Color fundus photograph
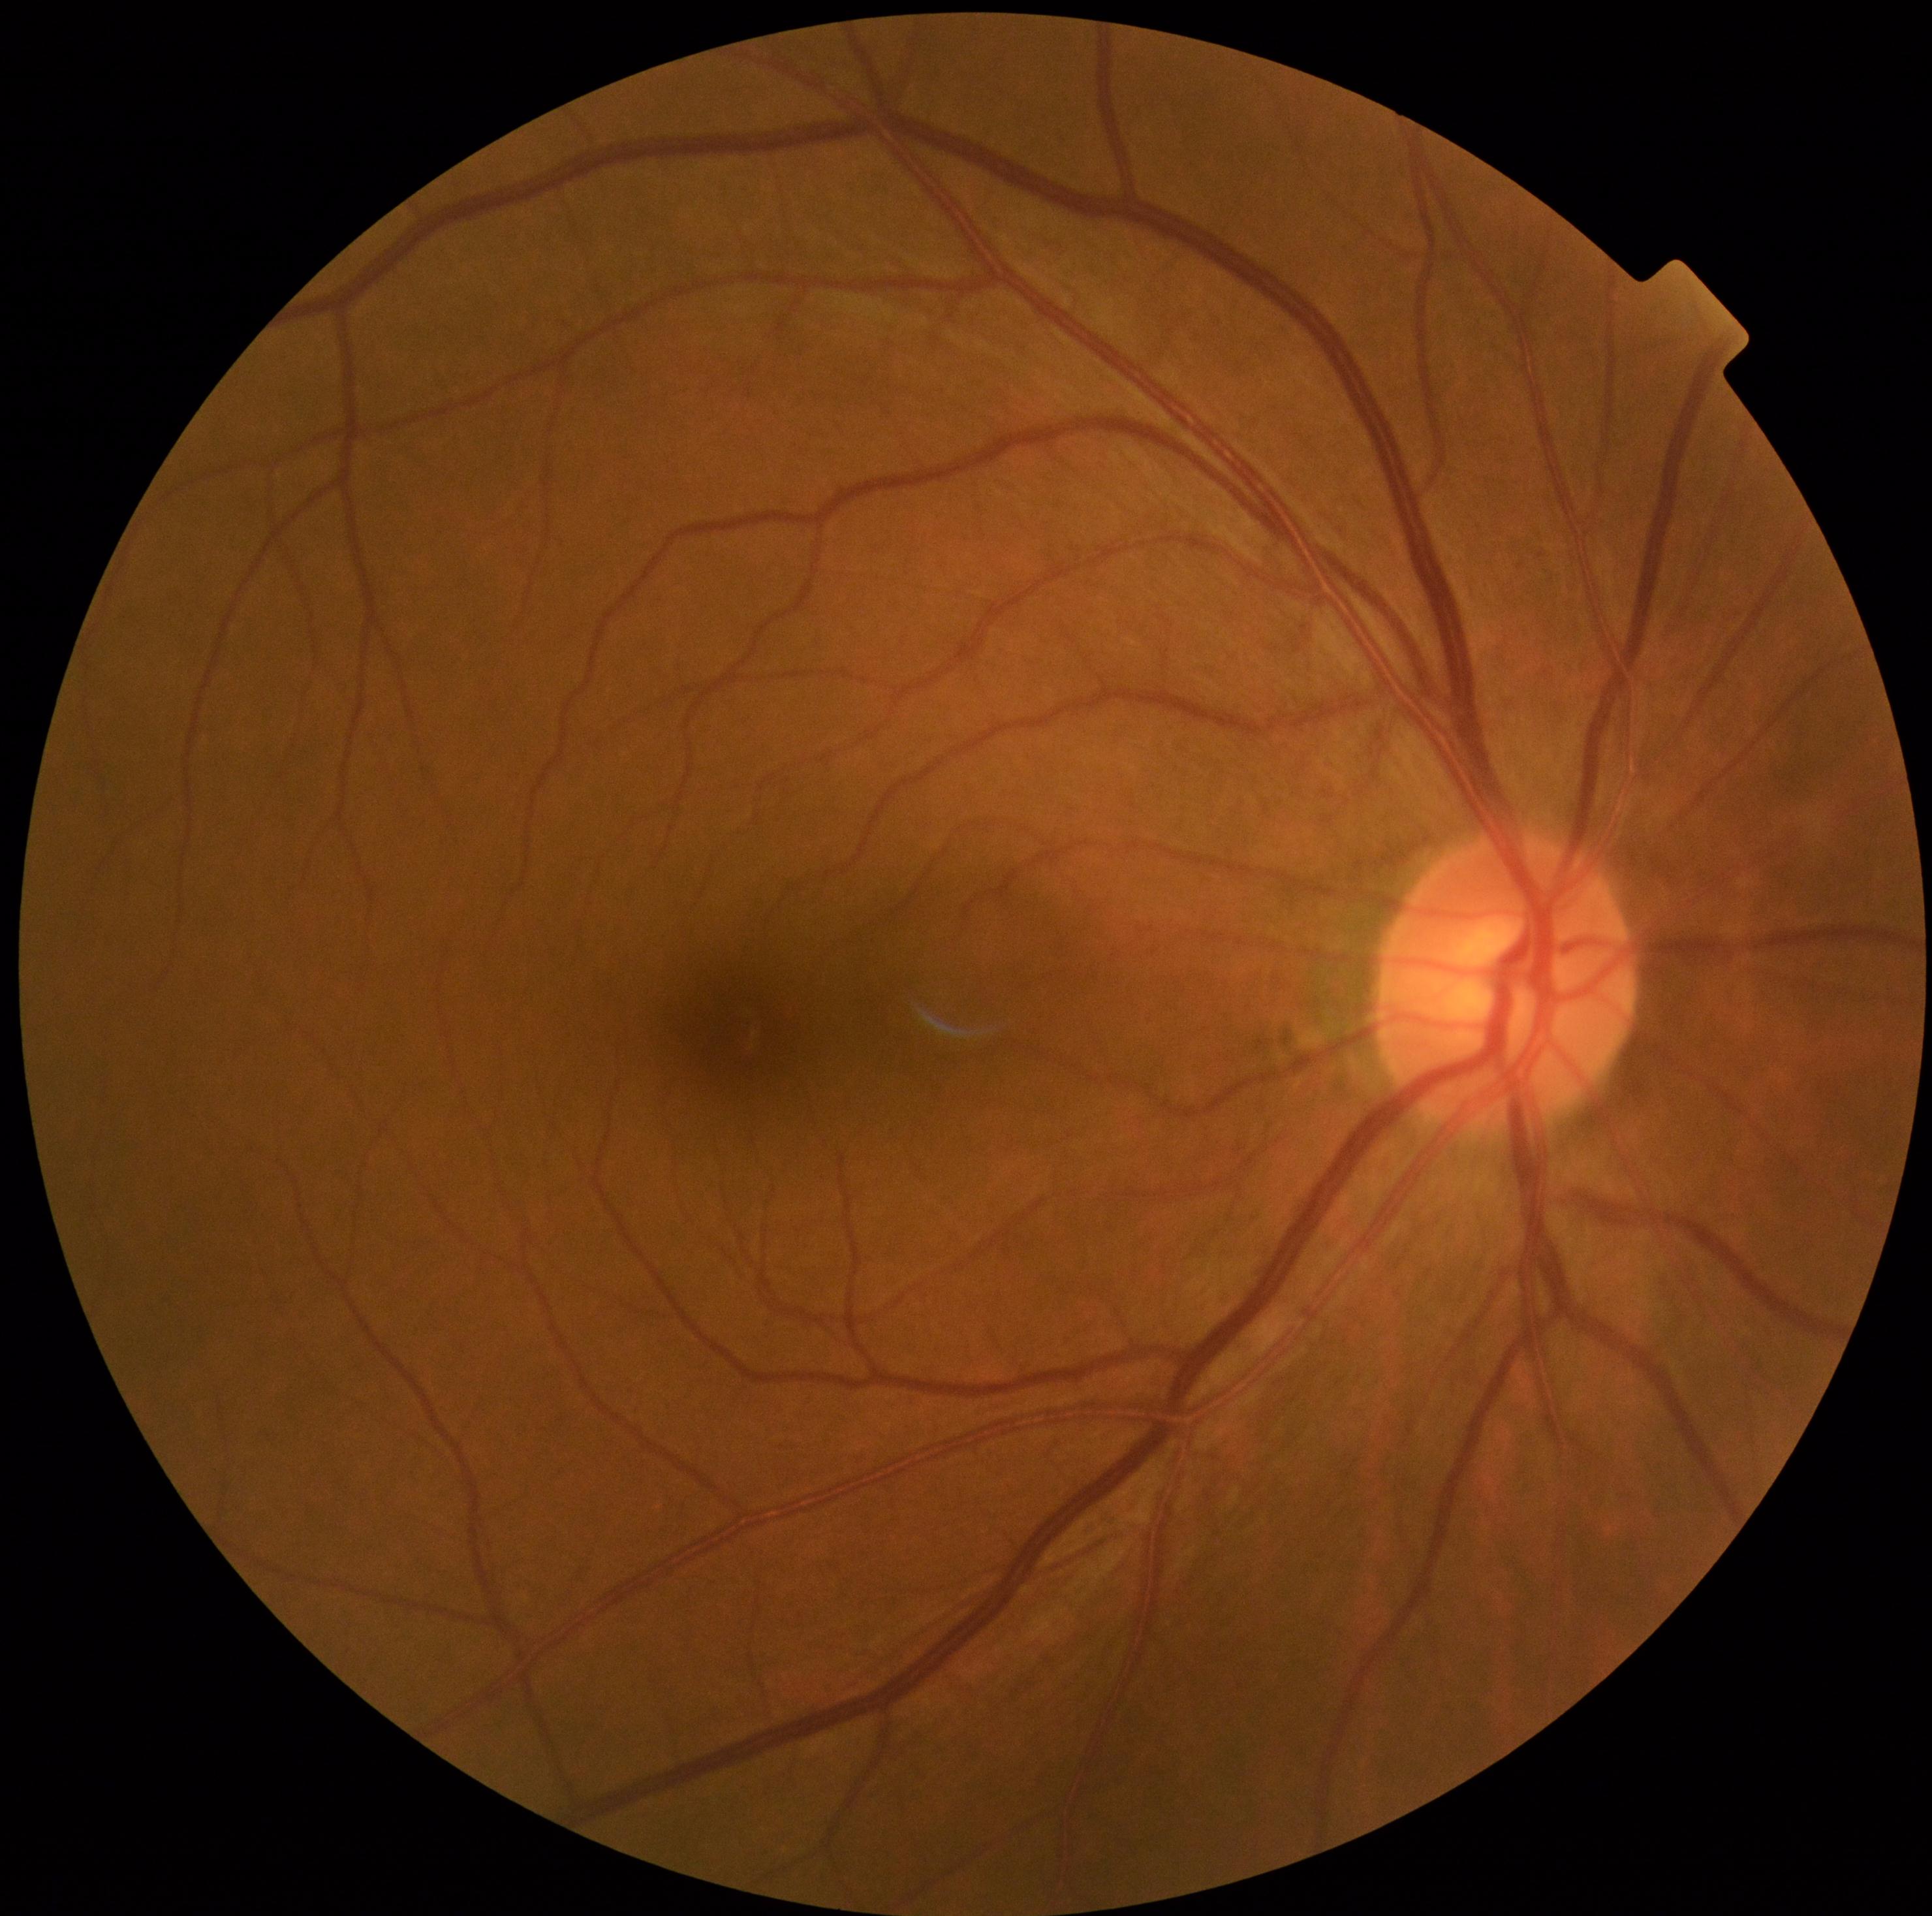
DR grade is no apparent retinopathy (0).